Captured on a Remidio FOP fundus camera · 1659 x 2212 pixels.
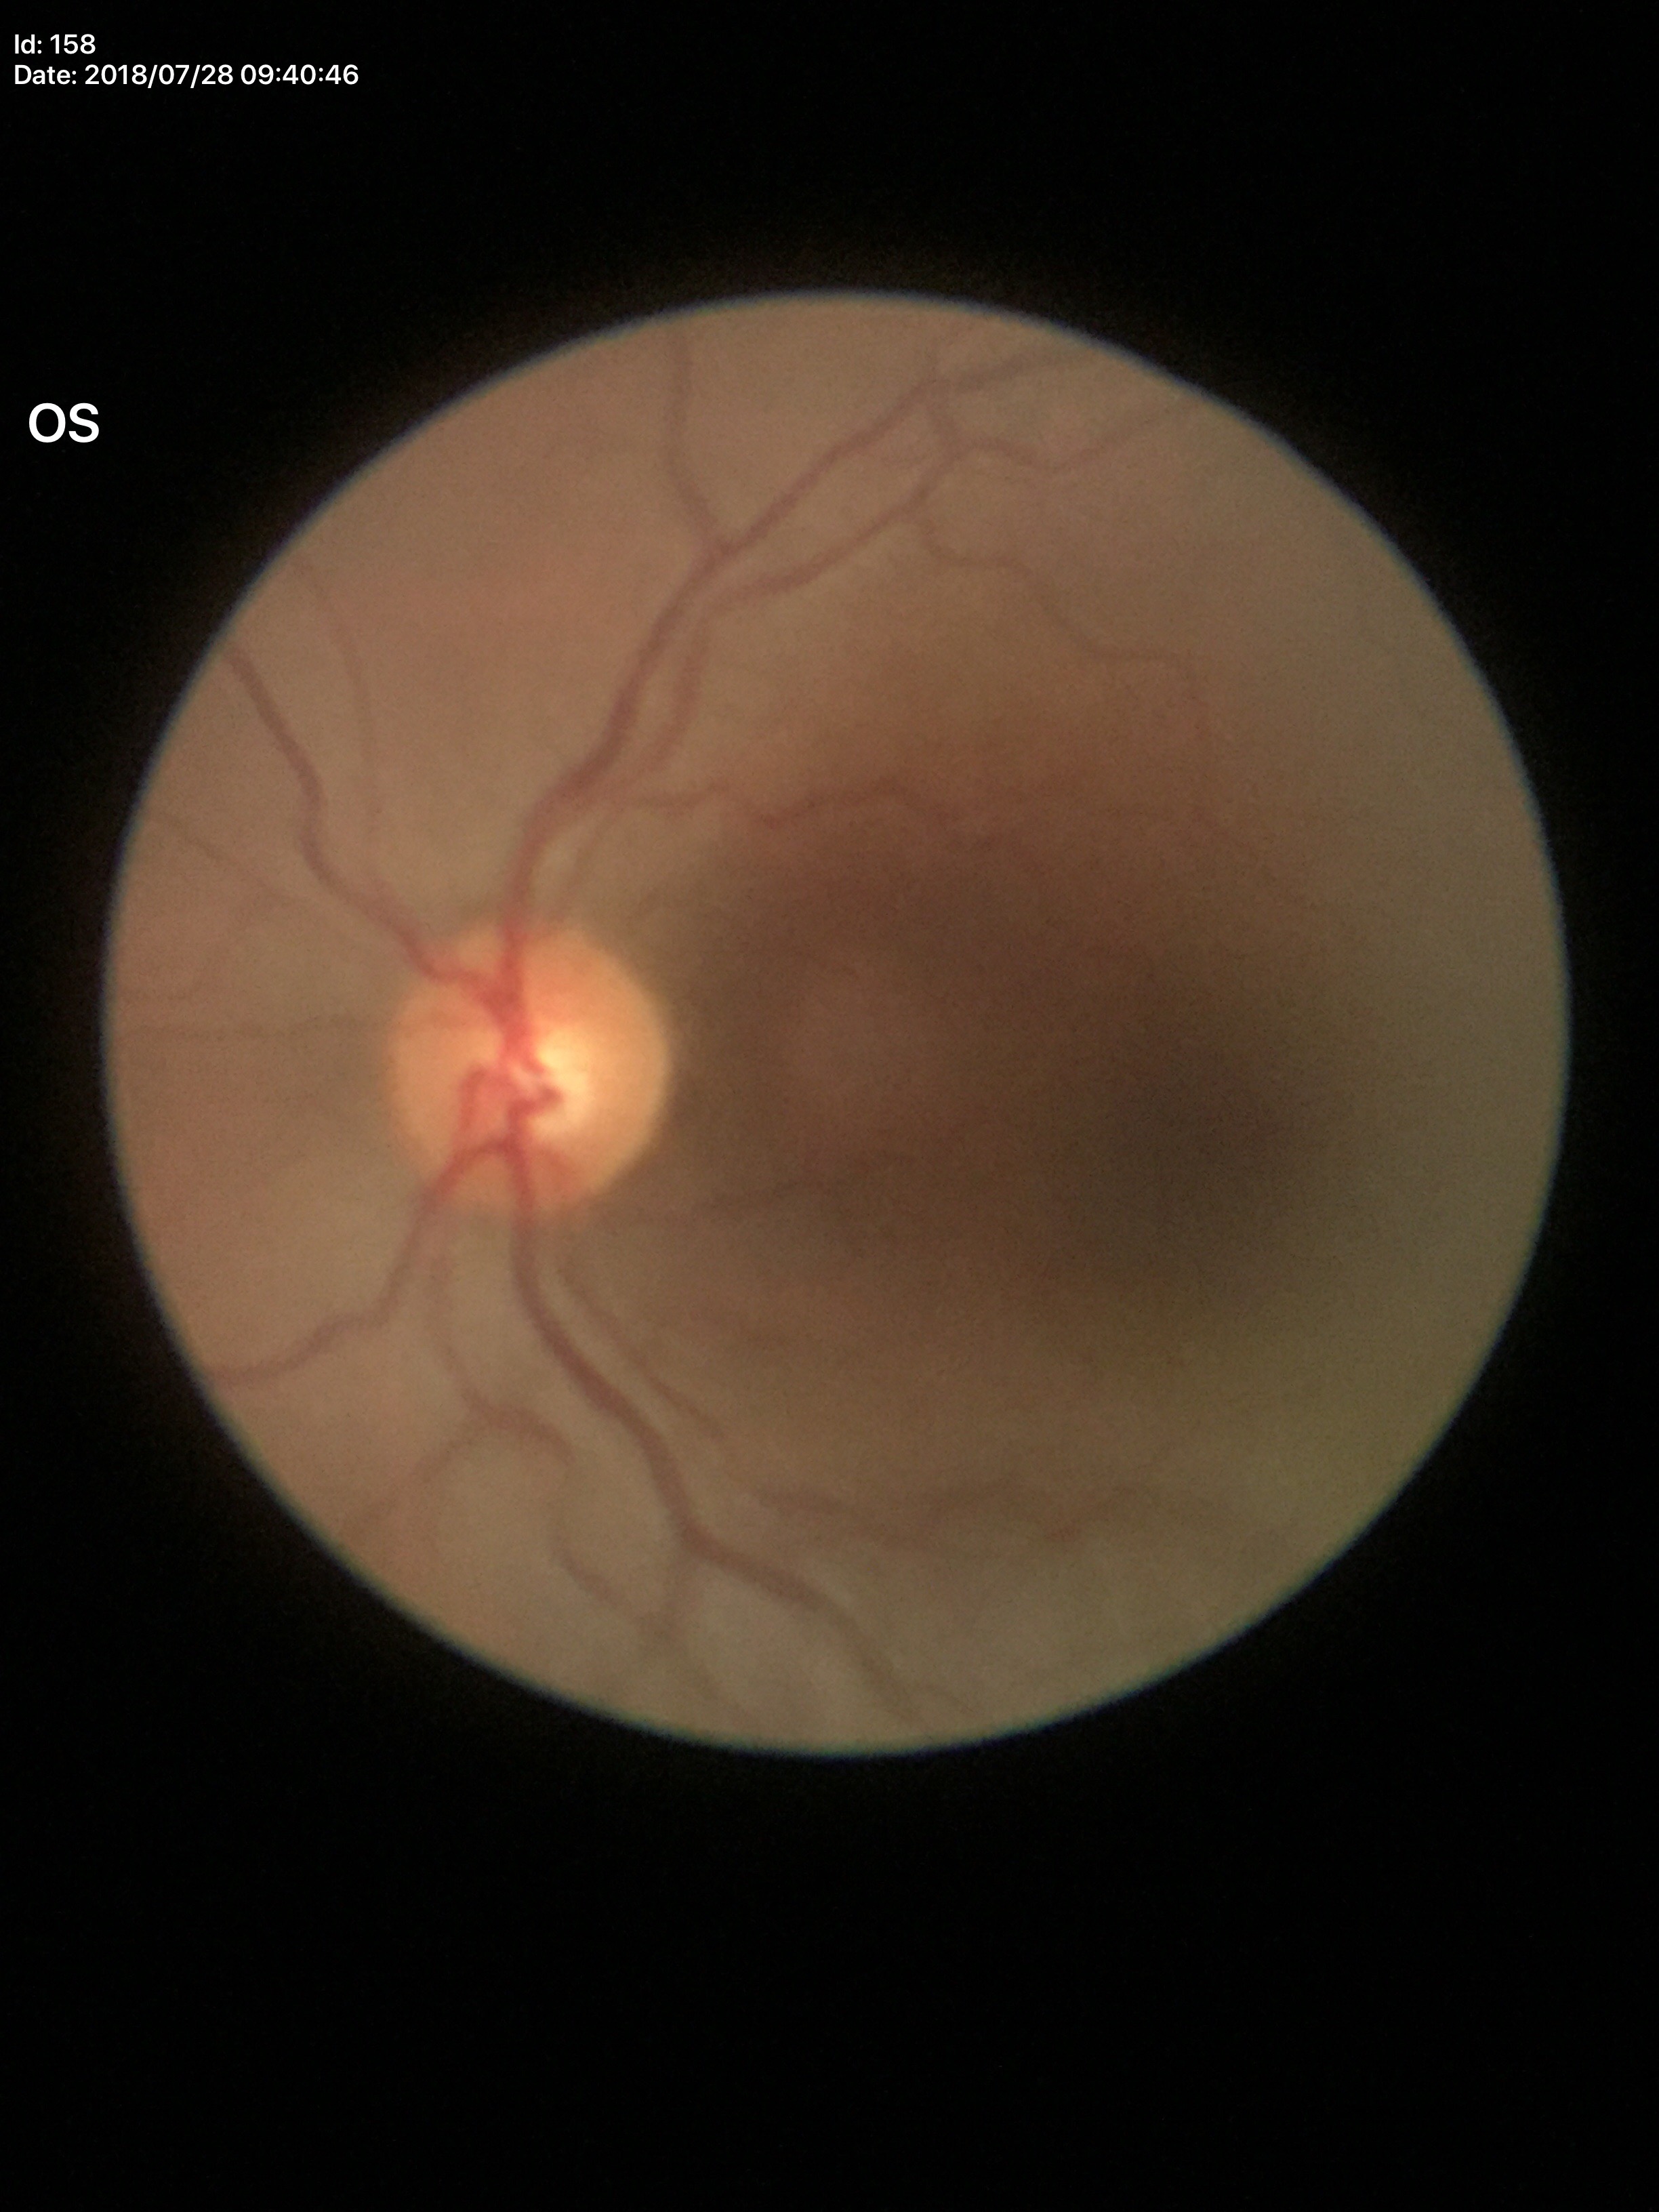 VCDR: 0.49.
Glaucoma evaluation: no suspicious findings (all 5 graders called normal).
HCDR of 0.48.